45° field of view:
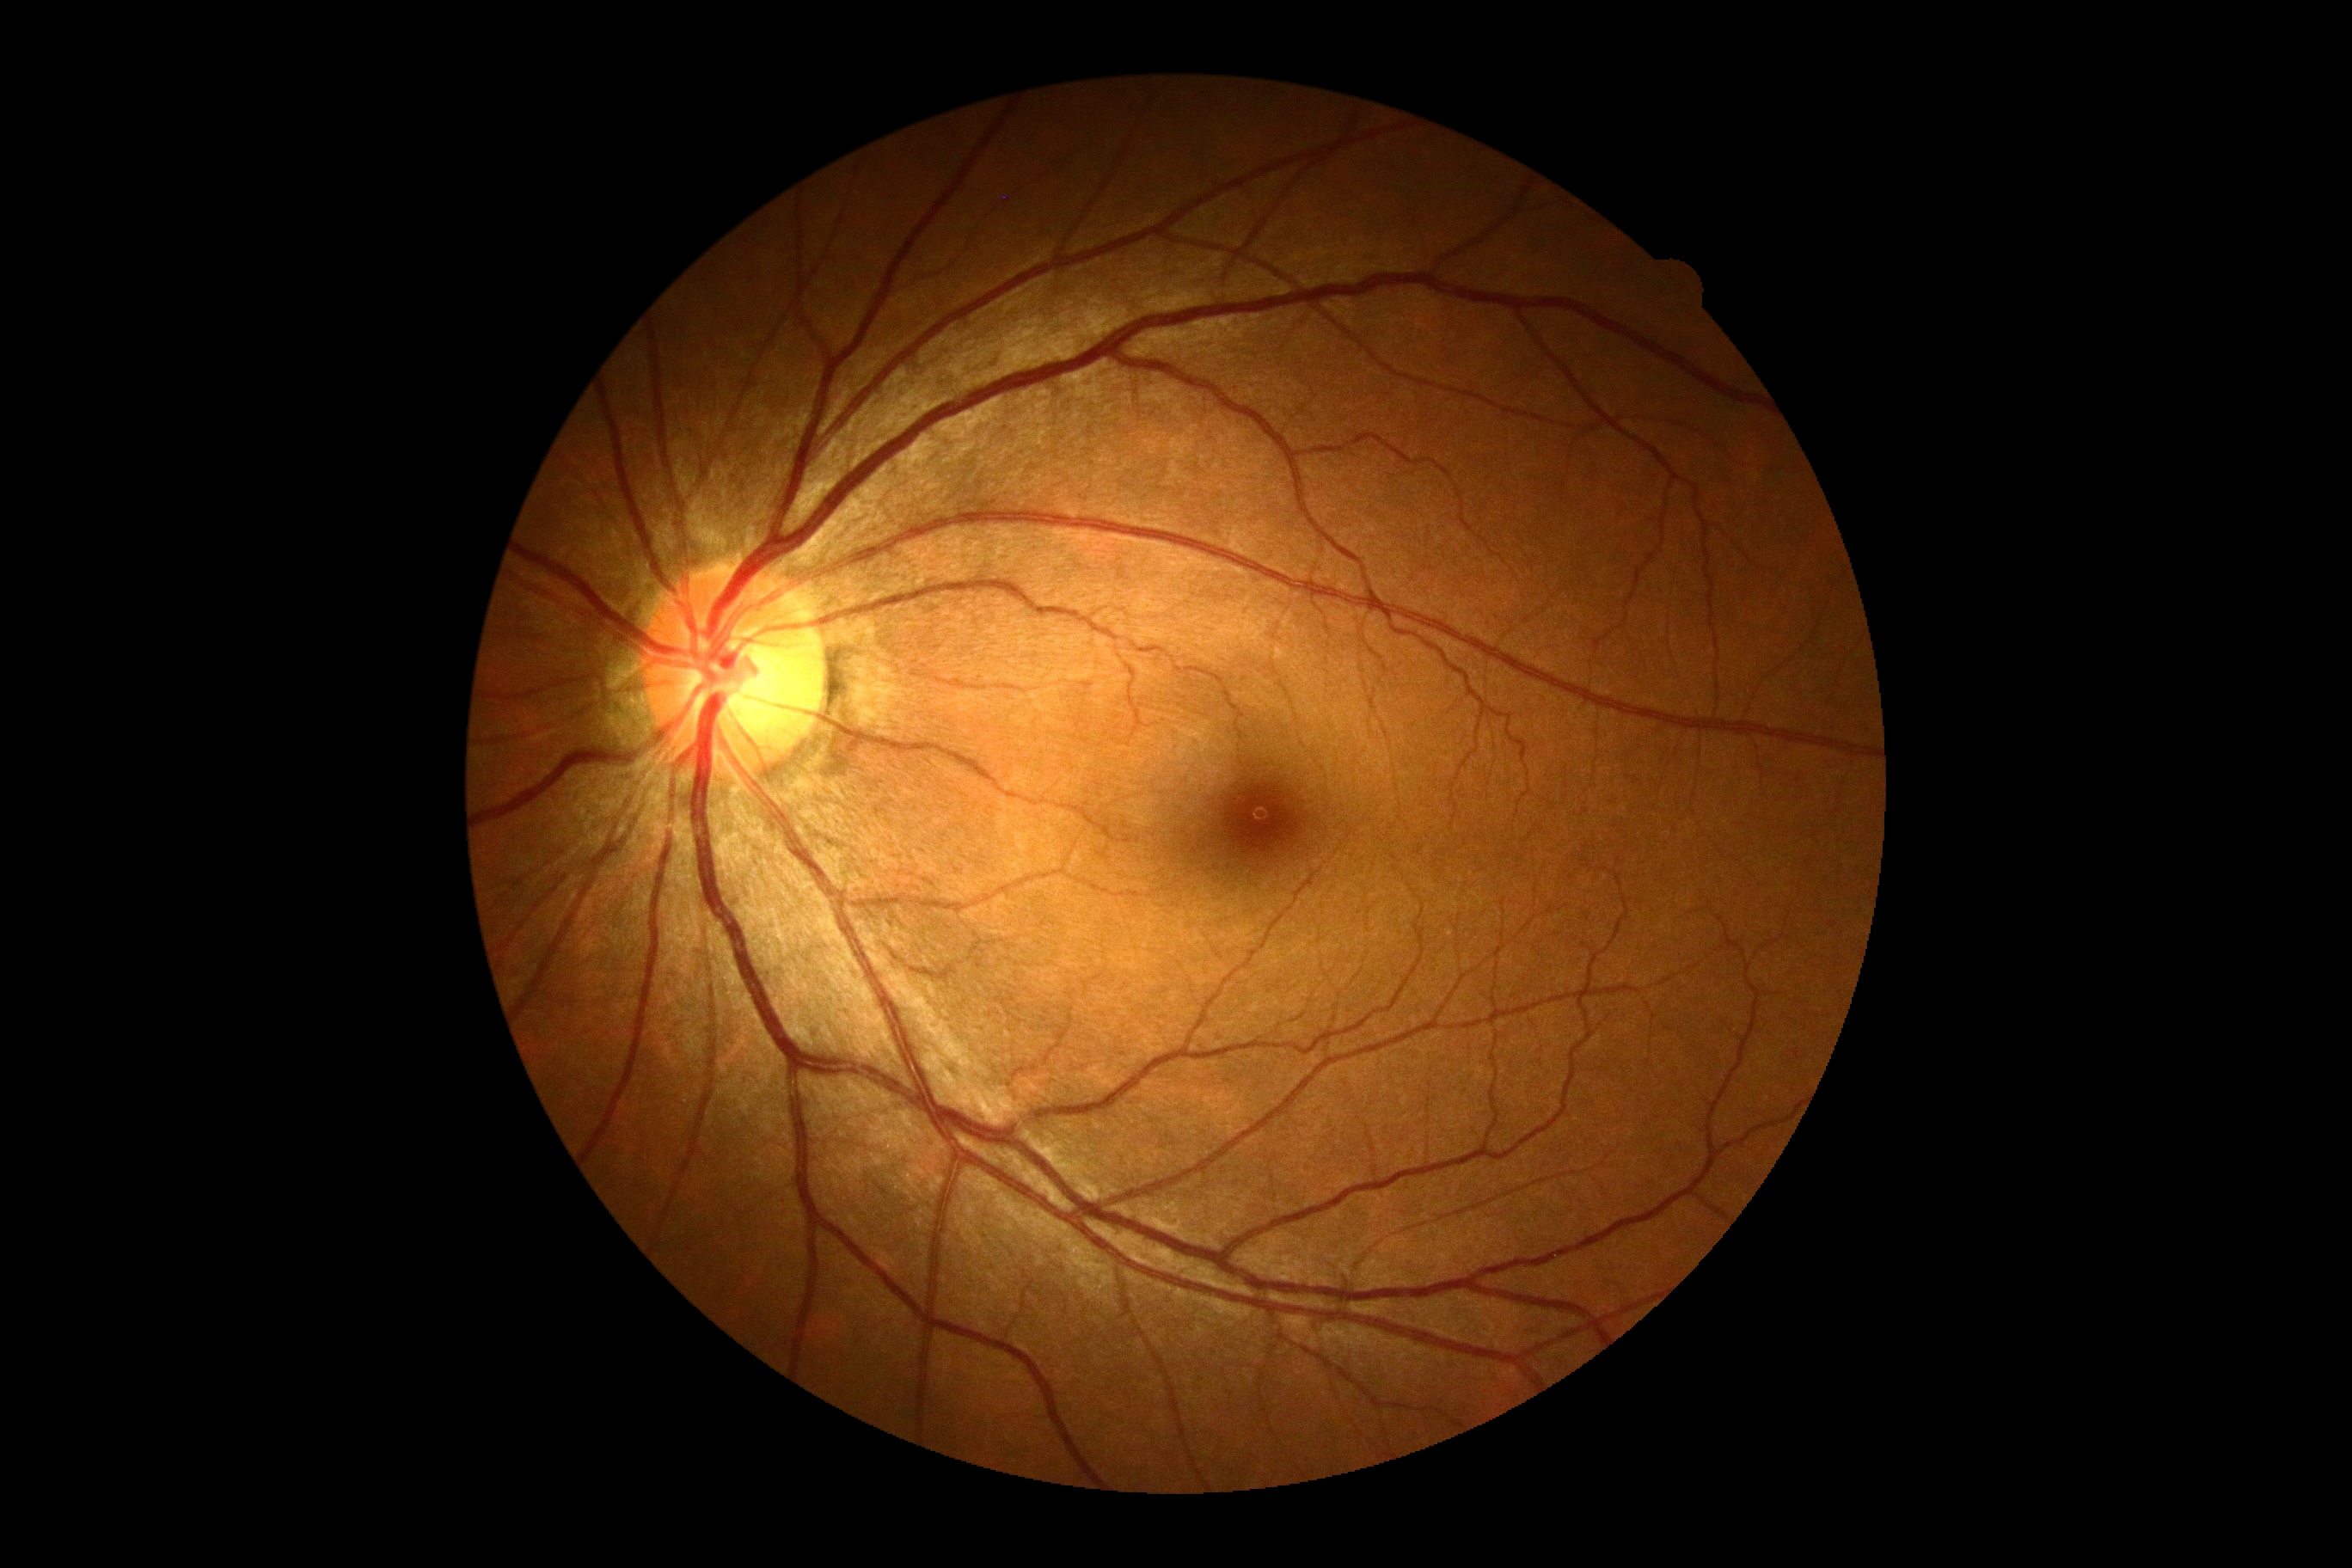
DR grade: 0 (no apparent retinopathy).
No DR findings.